1924 by 1556 pixels; wide-field retinal mosaic image; 200° FOV
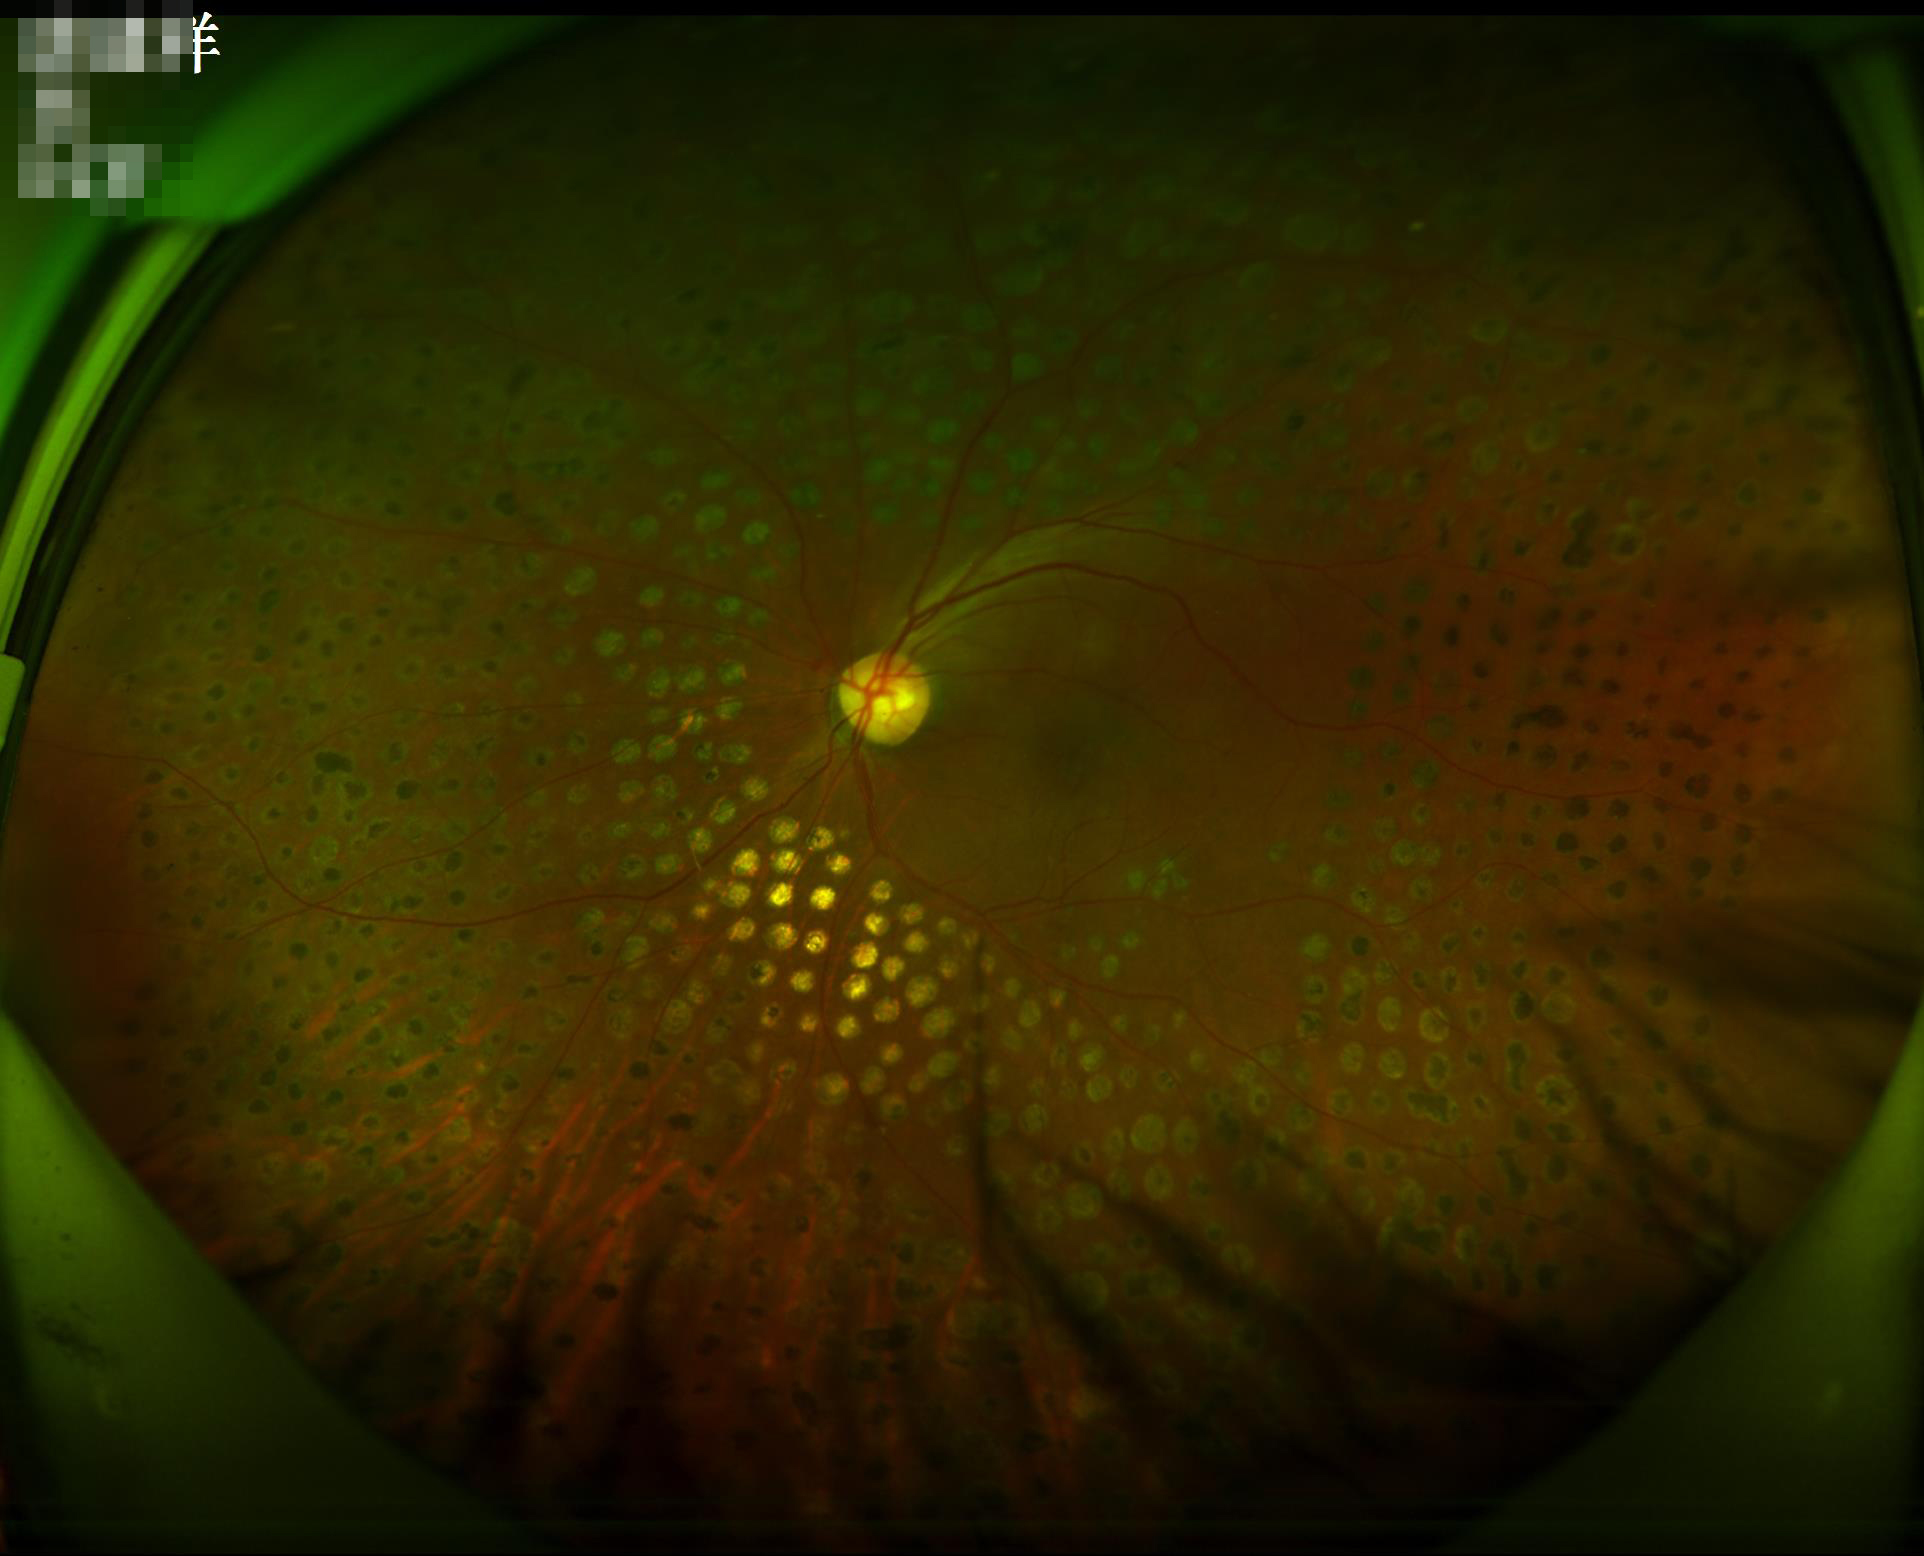
Illumination and color are suboptimal.
Image is sharp throughout the field.
Image quality is adequate for diagnostic use.
Vessels and details are readily distinguishable.